2346x1568; retinal fundus photograph — 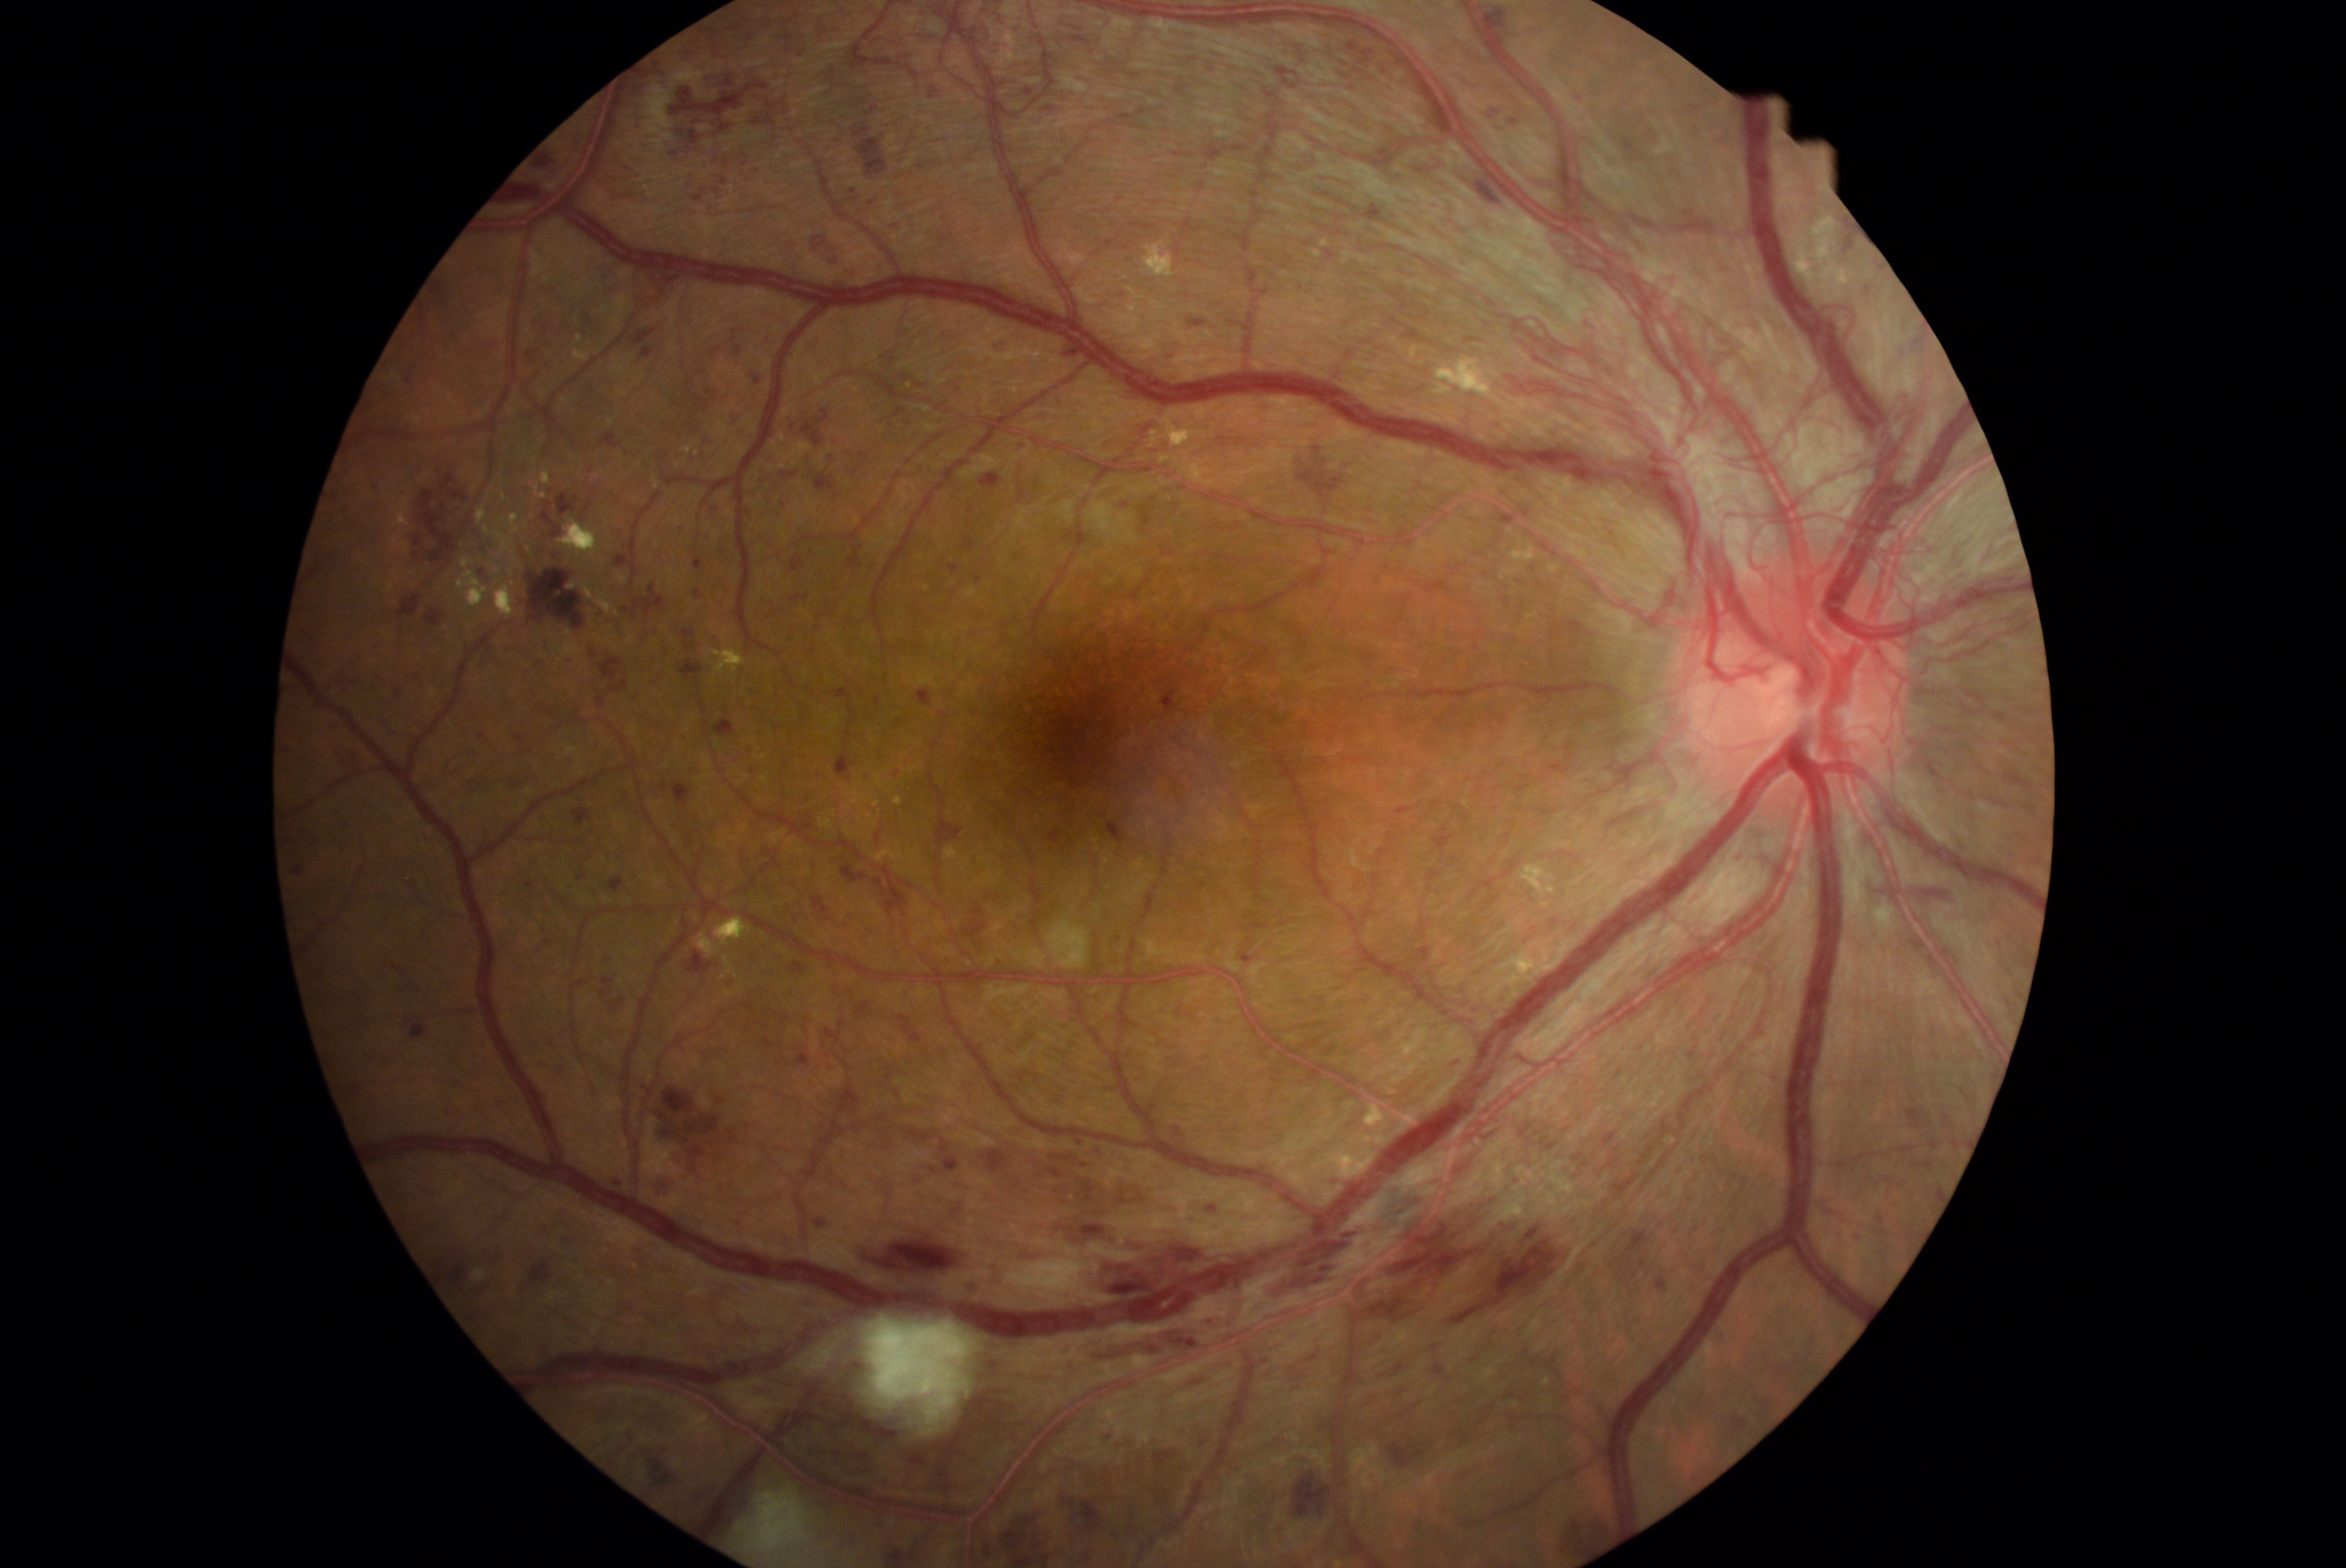 partial: true
dr_grade: 4
lesions:
  he:
    - 1908/1192/1925/1211
    - 1070/1548/1089/1552
    - 1048/829/1064/844
    - 374/675/387/686
    - 780/404/843/445
    - 617/554/631/567
    - 791/554/807/573
    - 1831/1230/1843/1240
    - 760/451/840/515
    - 1273/1522/1288/1536
    - 620/631/630/639
    - 409/877/423/906
    - 1059/343/1083/363
    - 594/609/606/617
    - 1260/1428/1295/1454
    - 590/677/628/710
    - 1163/335/1186/361
  he_small_centers:
    - x=1937 y=1057
    - x=610 y=959